45-degree field of view:
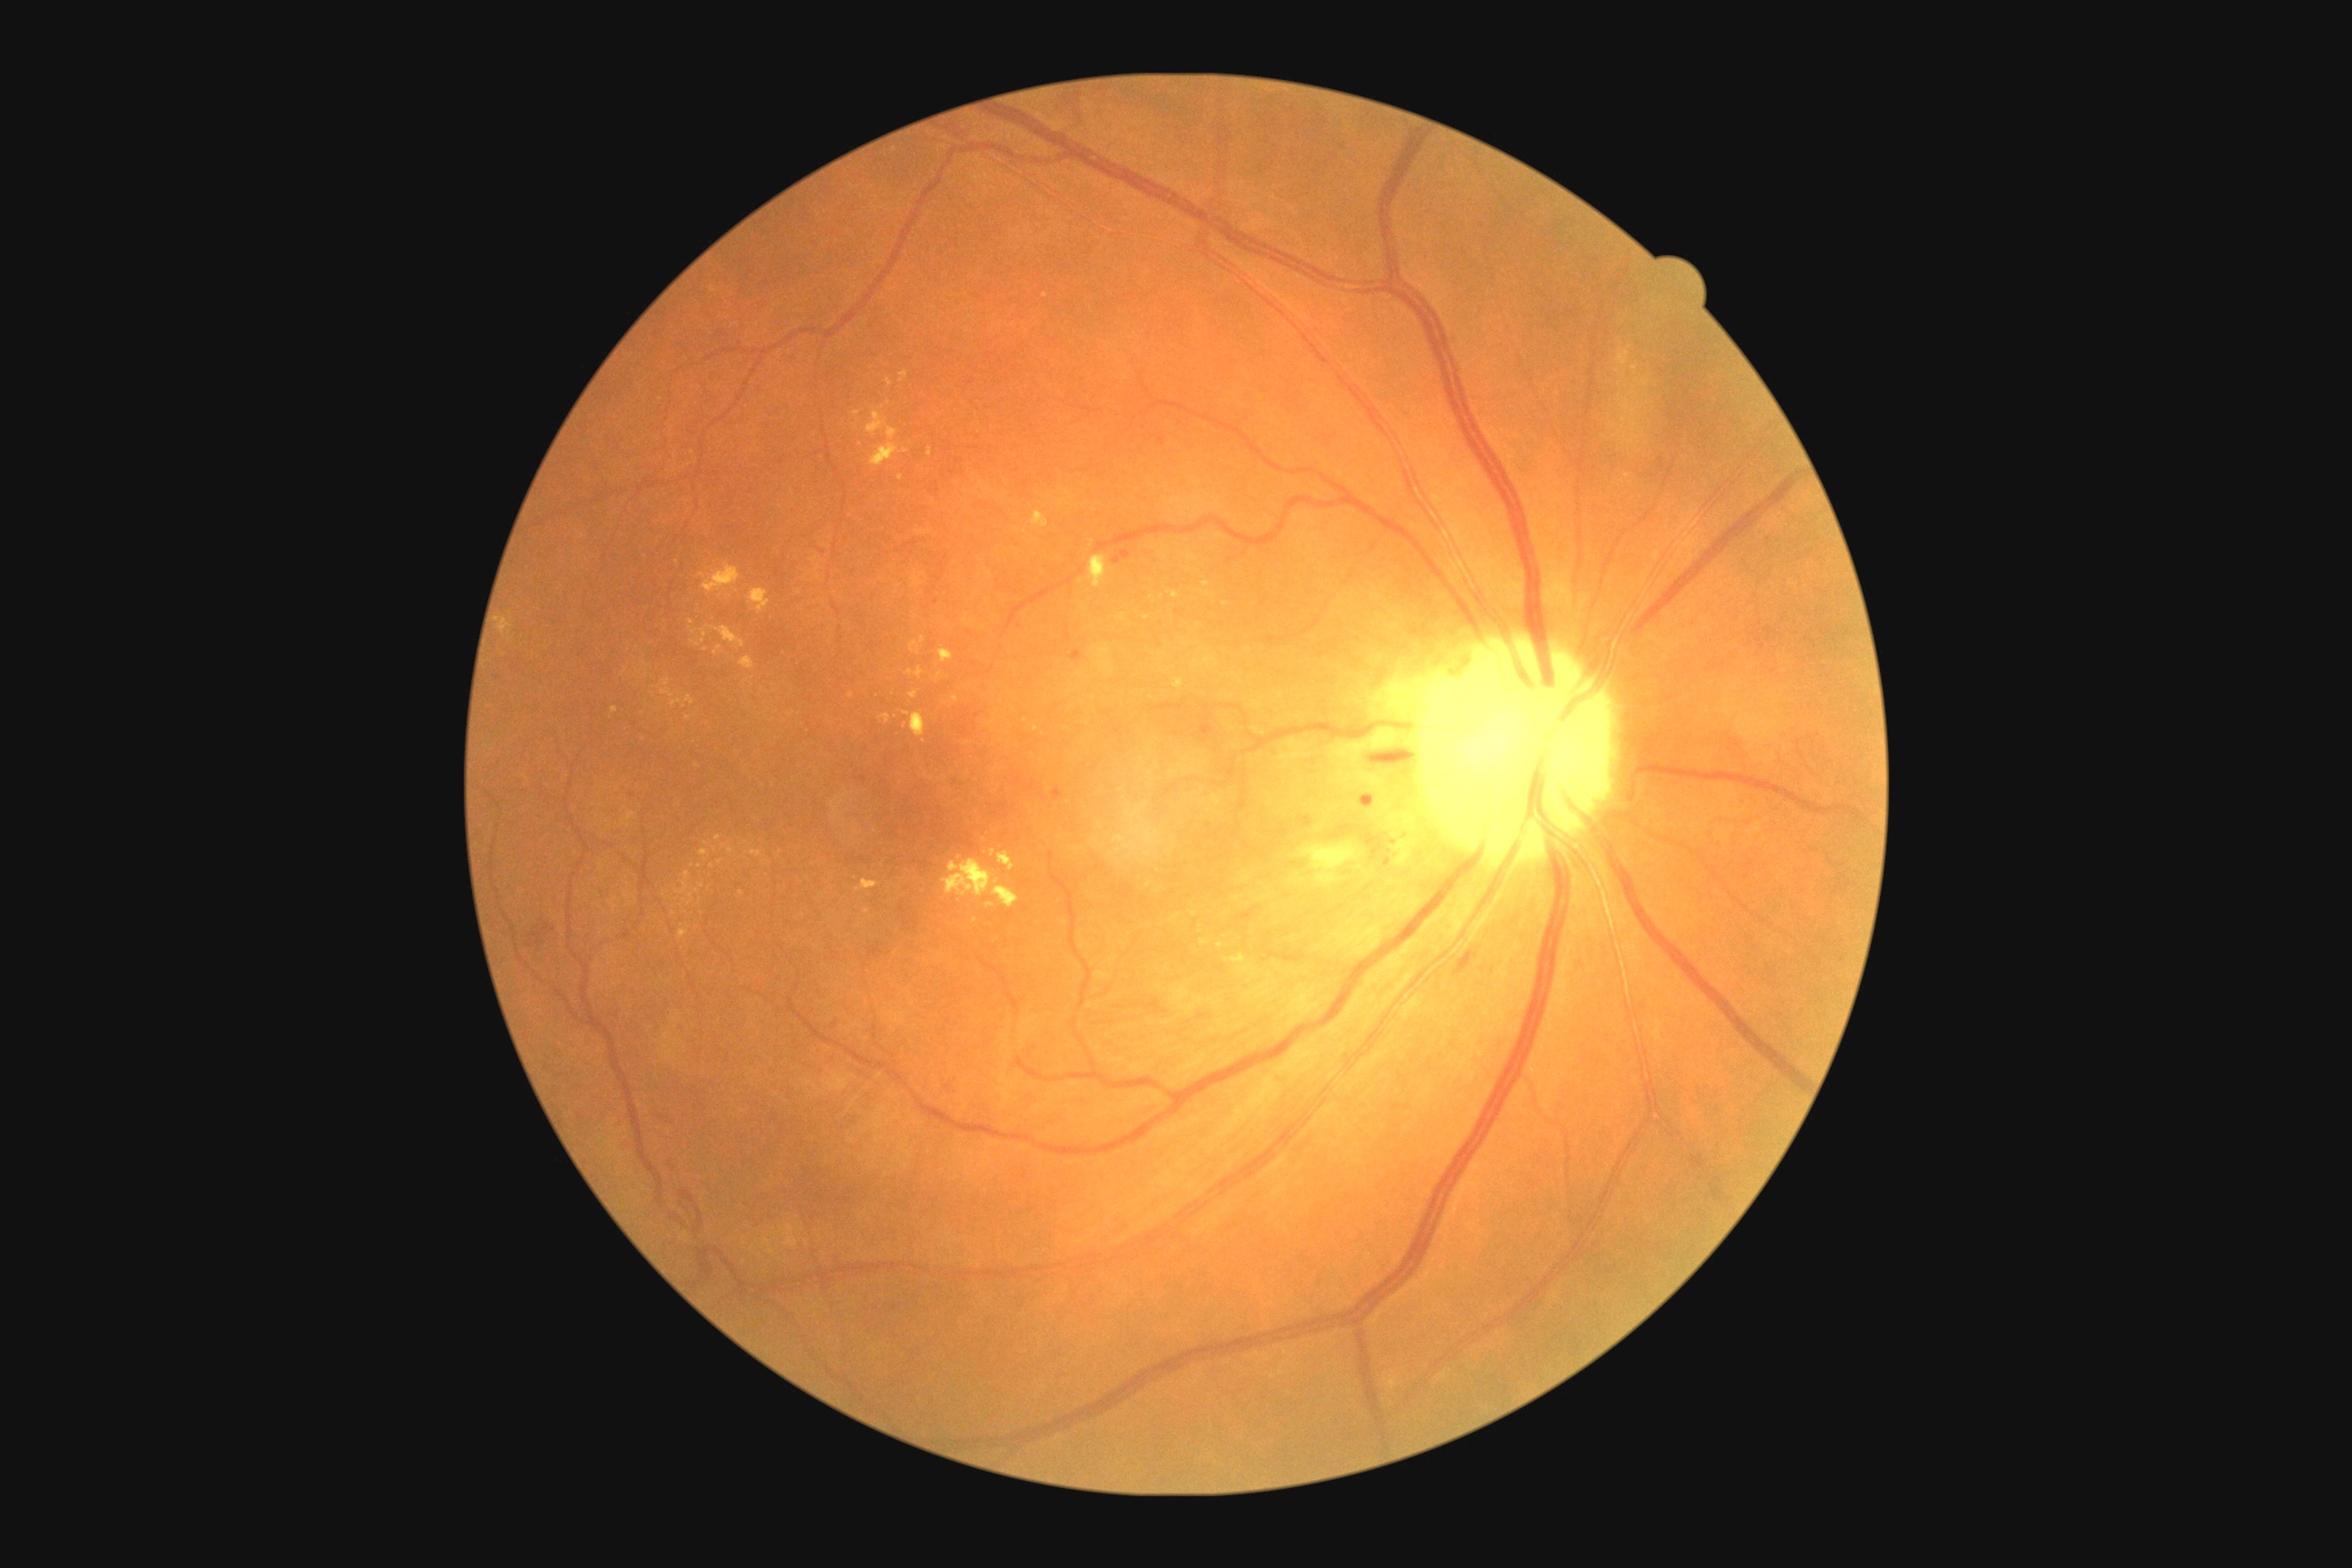
Diabetic retinopathy (DR): moderate NPDR (grade 2)
A subset of detected lesions:
hard exudates (EXs) (continued): 916 667 925 680; 906 669 914 676; 700 848 710 858; 1202 582 1211 587; 740 656 756 671; 678 881 689 896; 1631 366 1638 375; 865 908 870 916; 703 564 741 593; 689 627 698 634; 912 712 926 738
Small EXs approximately at pt(720, 863); pt(691, 622); pt(647, 703); pt(689, 926); pt(904, 451); pt(1120, 790); pt(781, 854); pt(1045, 296)